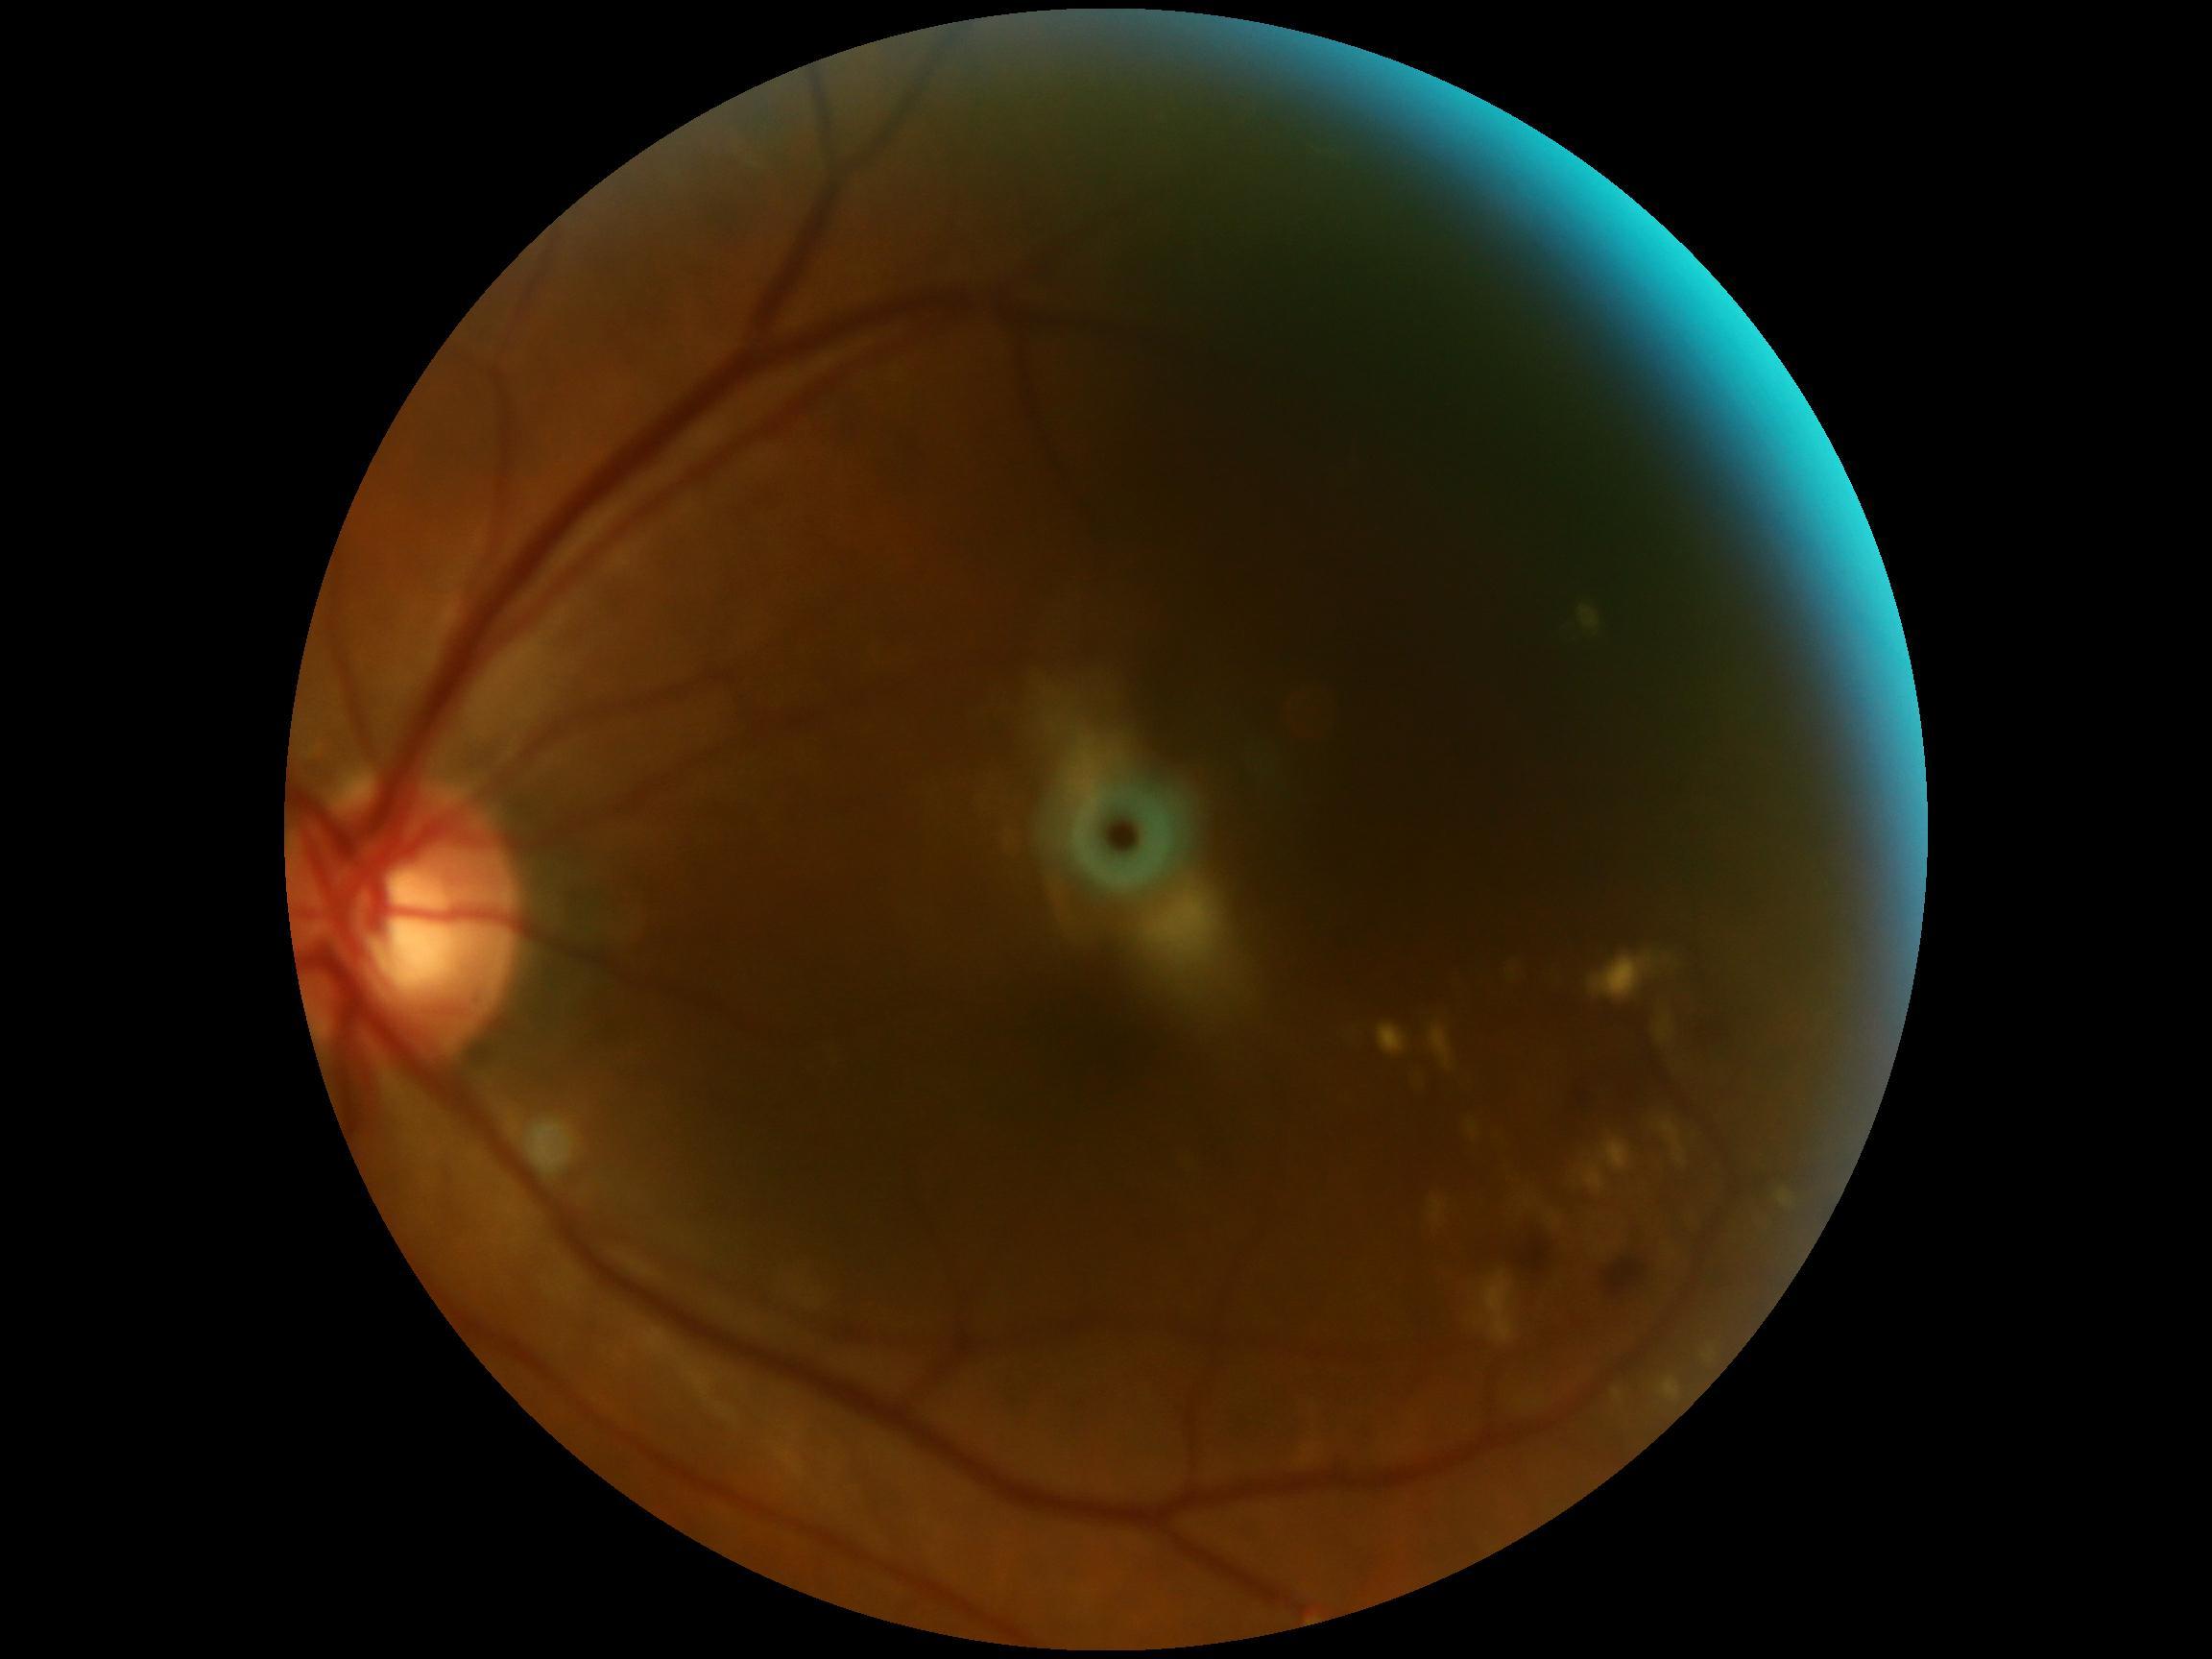

DR class: non-proliferative diabetic retinopathy. Diabetic retinopathy: 2.